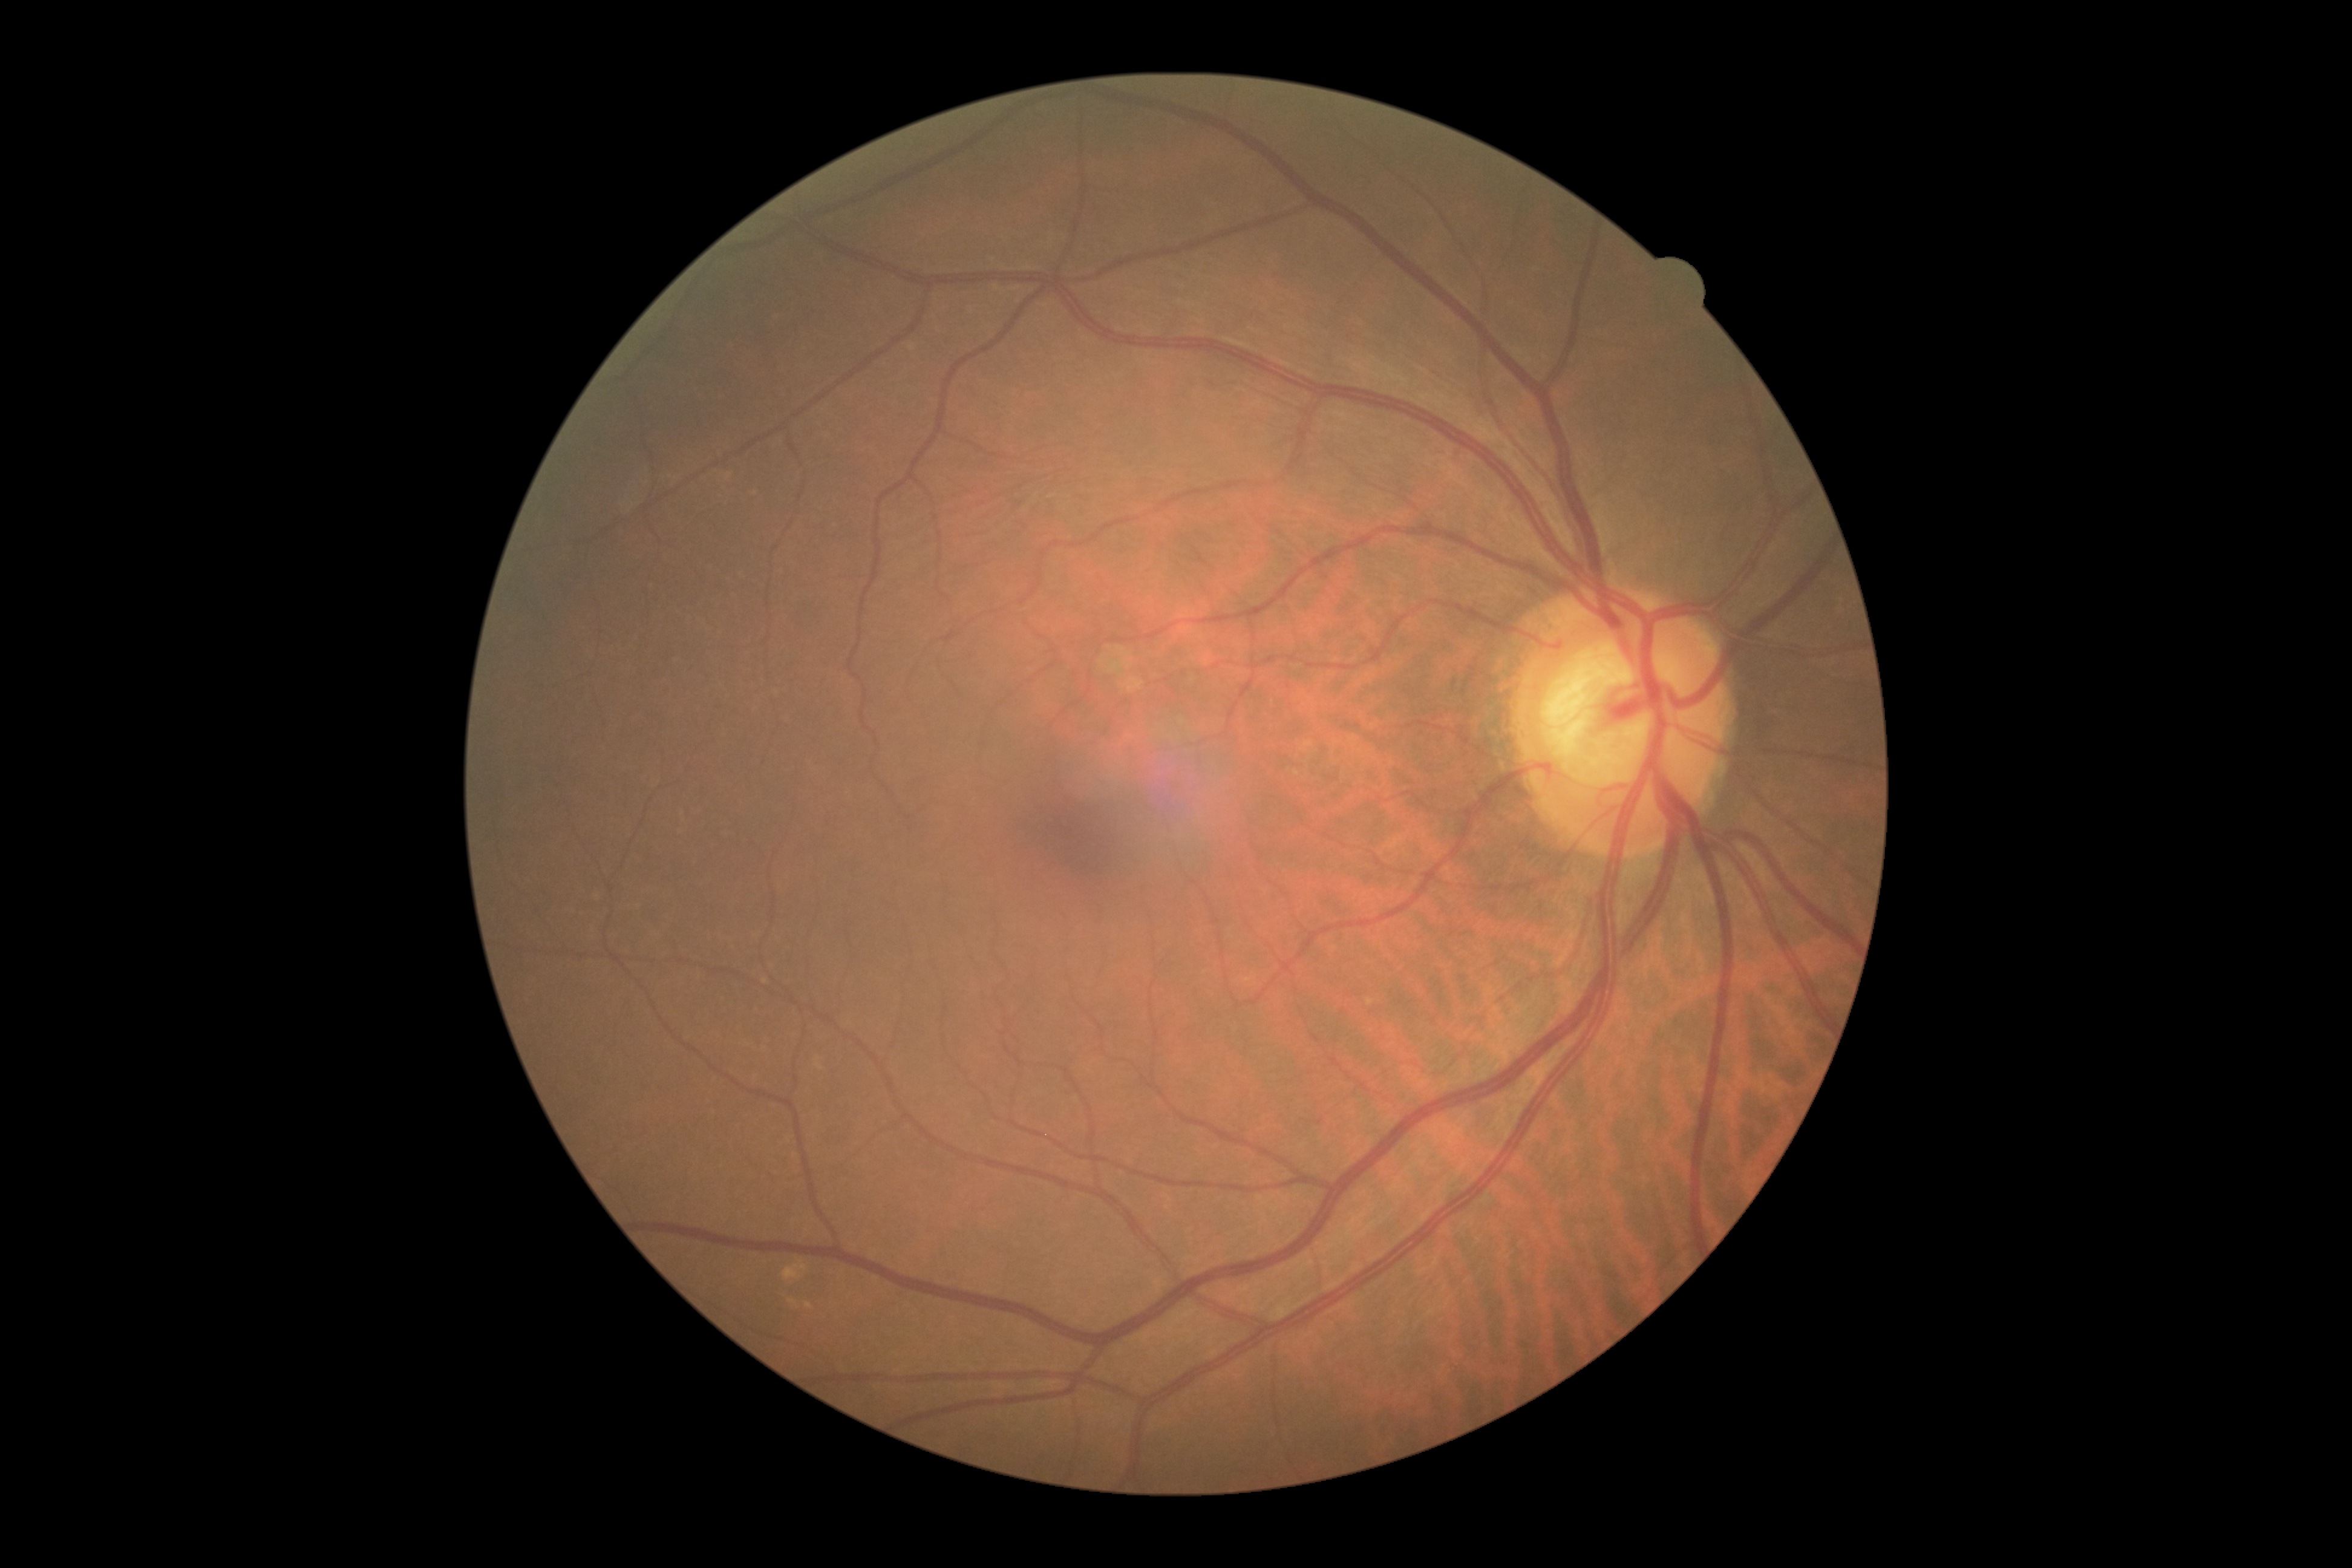
DR severity is no apparent diabetic retinopathy (grade 0).